1659x2212.
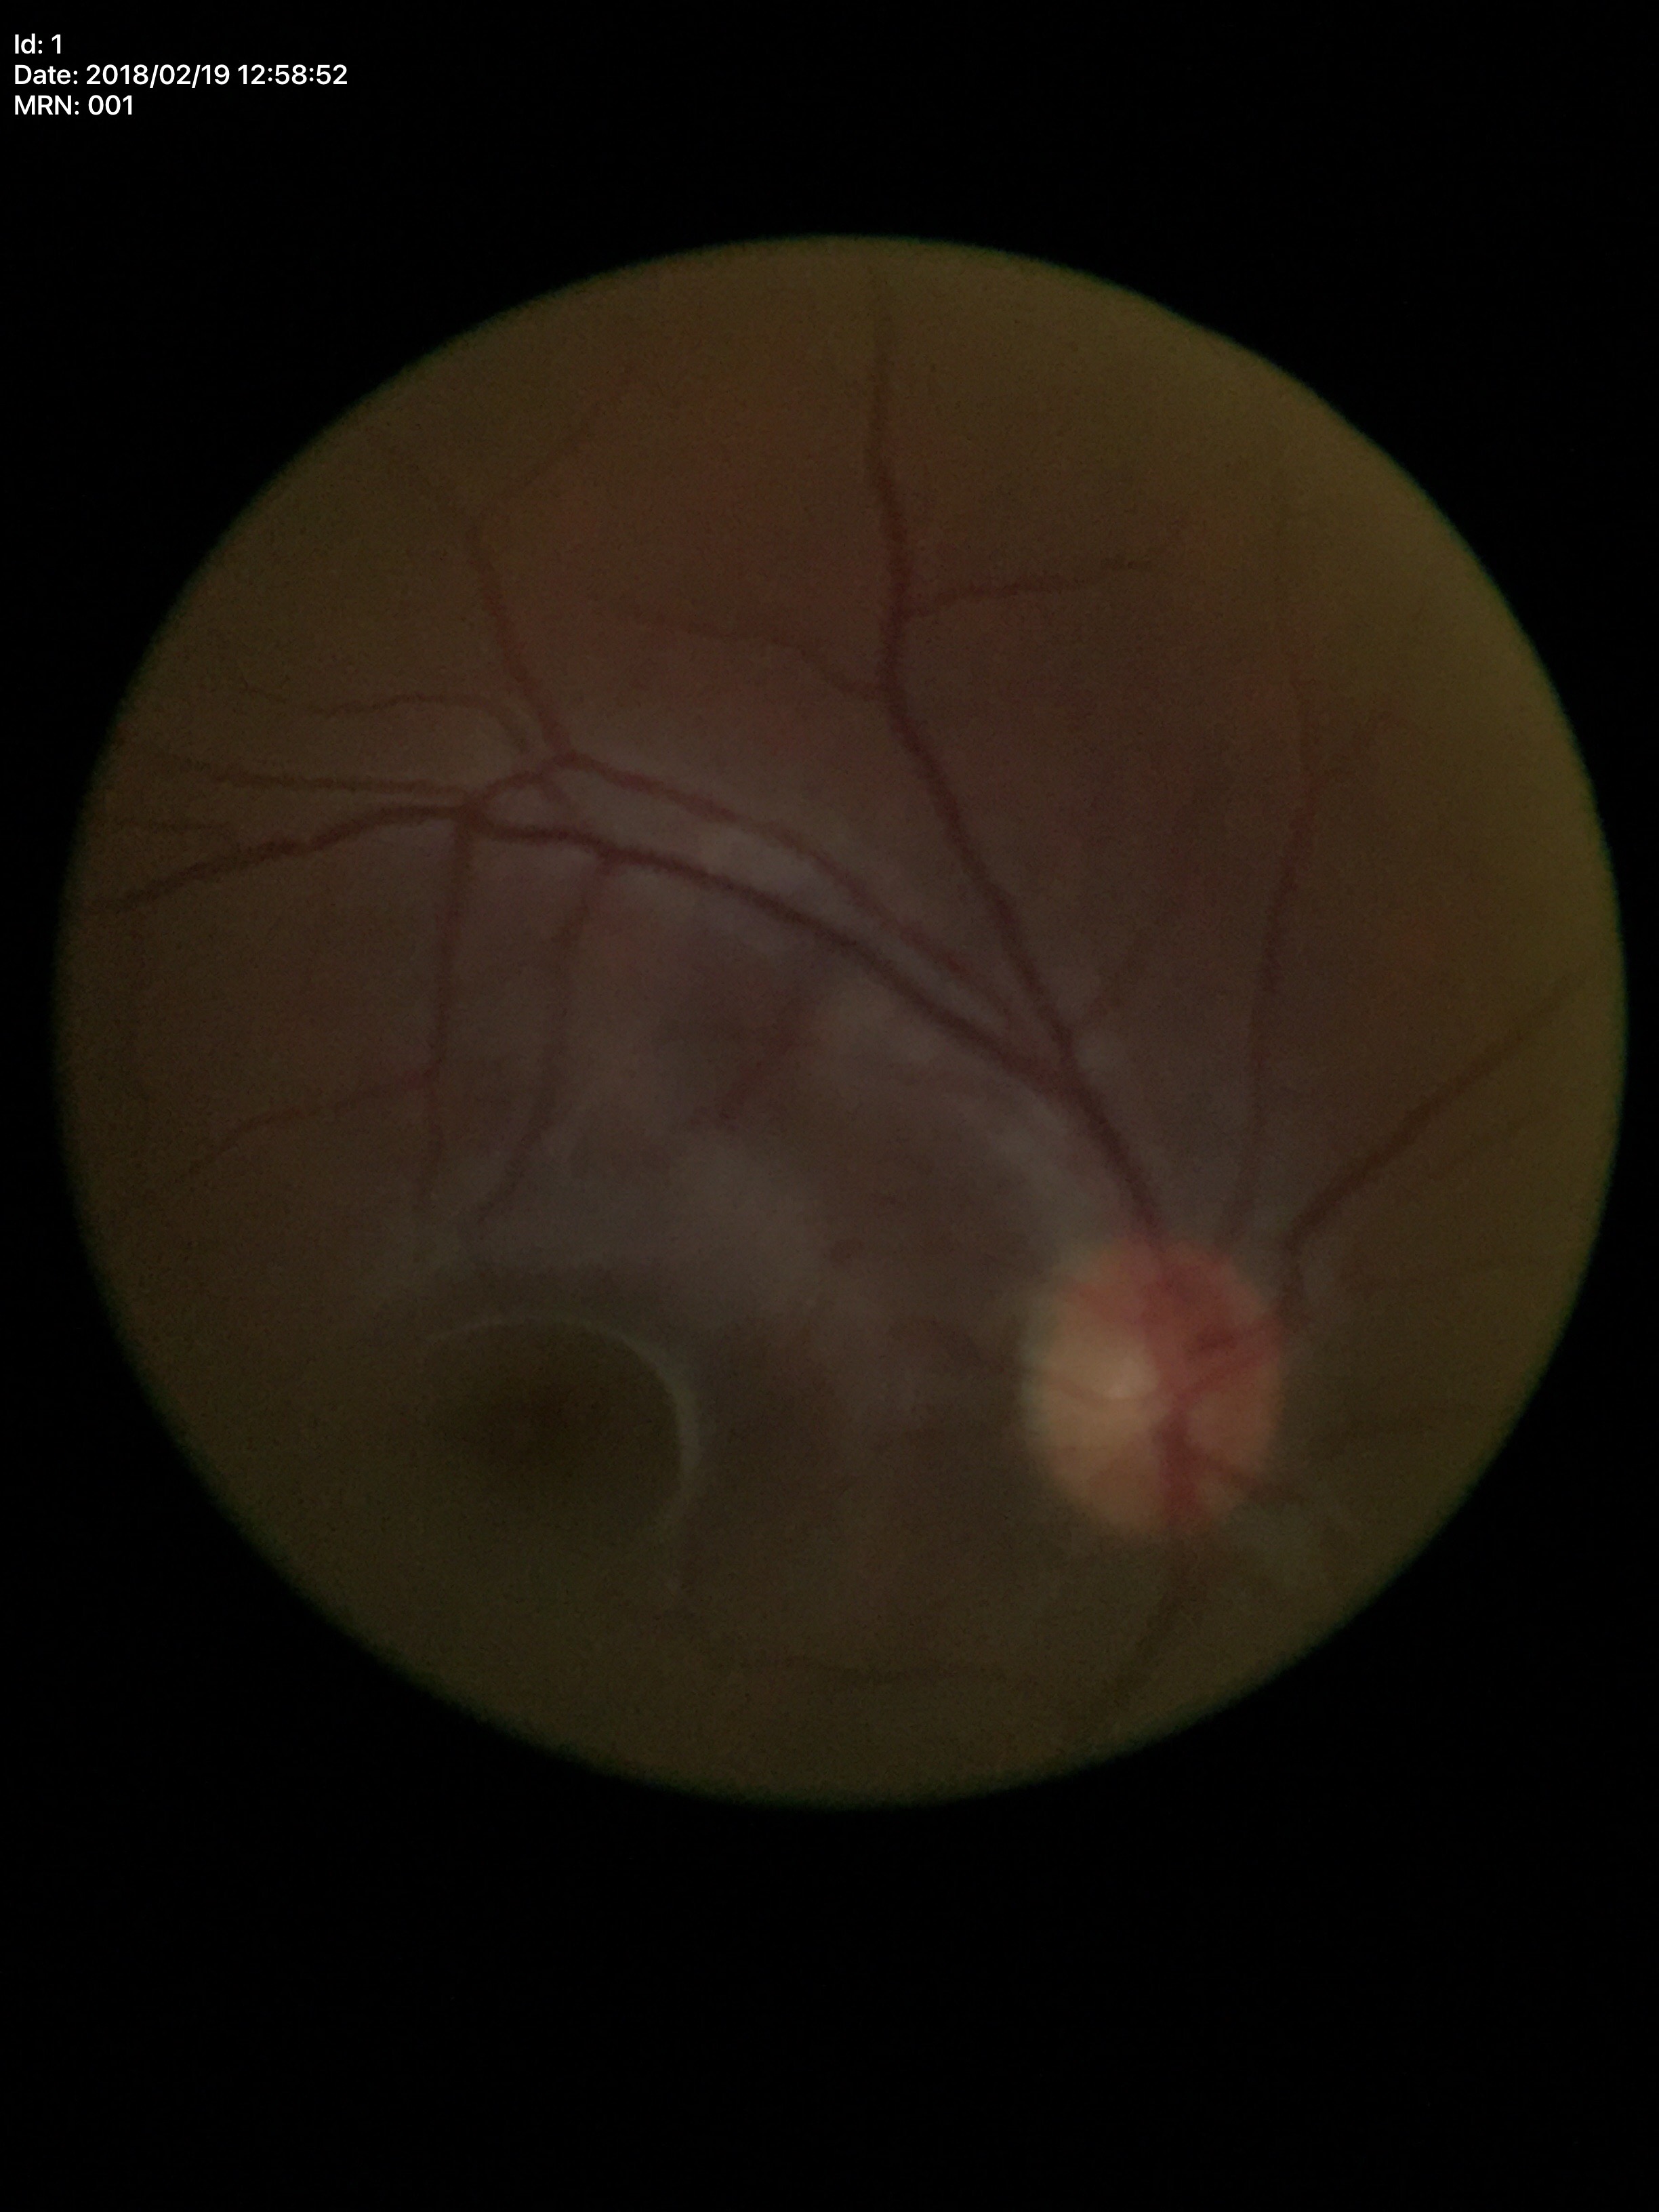
Area C/D ratio of 0.17.
Horizontal C/D ratio of 0.43.
No glaucomatous findings (unanimous normal call).
Vertical cup-disc ratio: 0.42.